No pharmacologic dilation. 848x848px. Color fundus image.
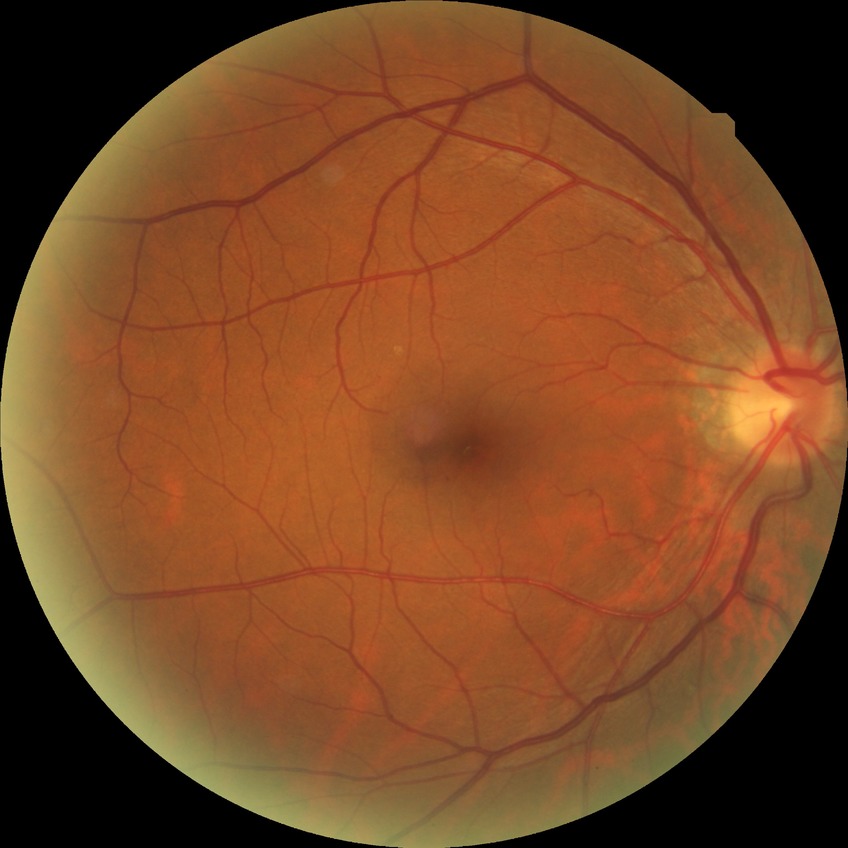

Diabetic retinopathy grade: simple diabetic retinopathy.